45-degree field of view.
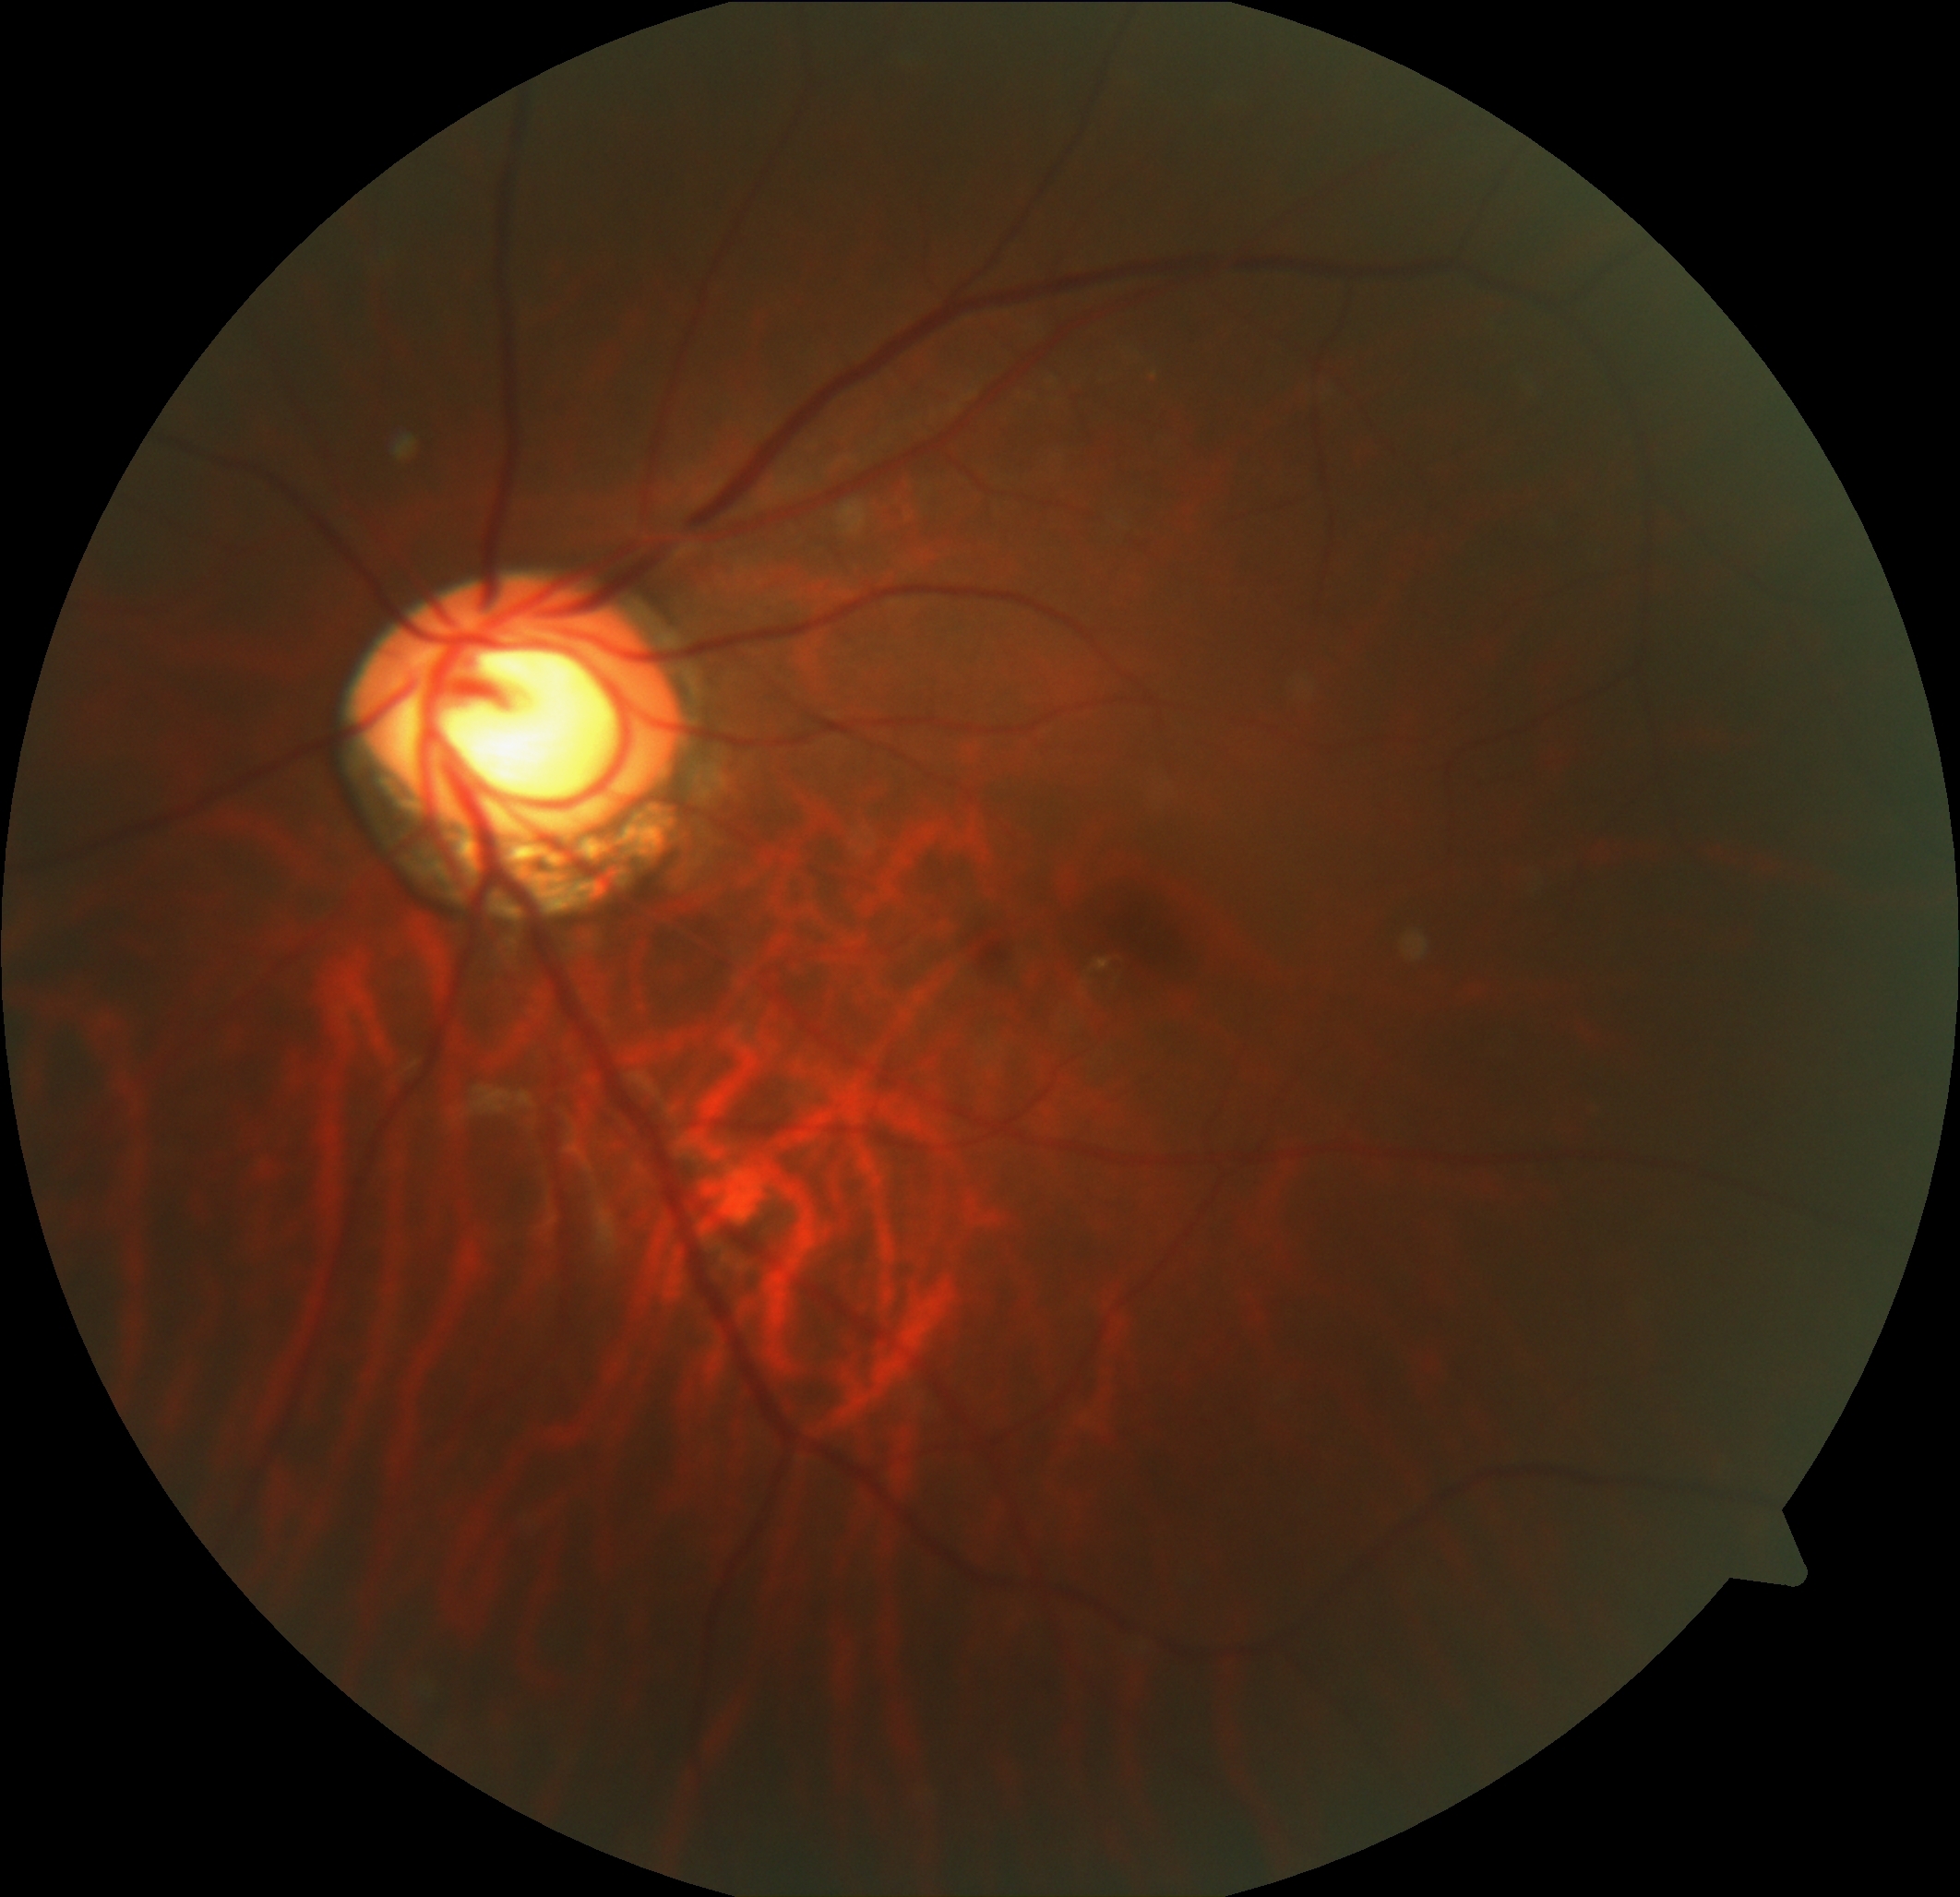 diabetic retinopathy (DR)=grade 0 (no apparent retinopathy).